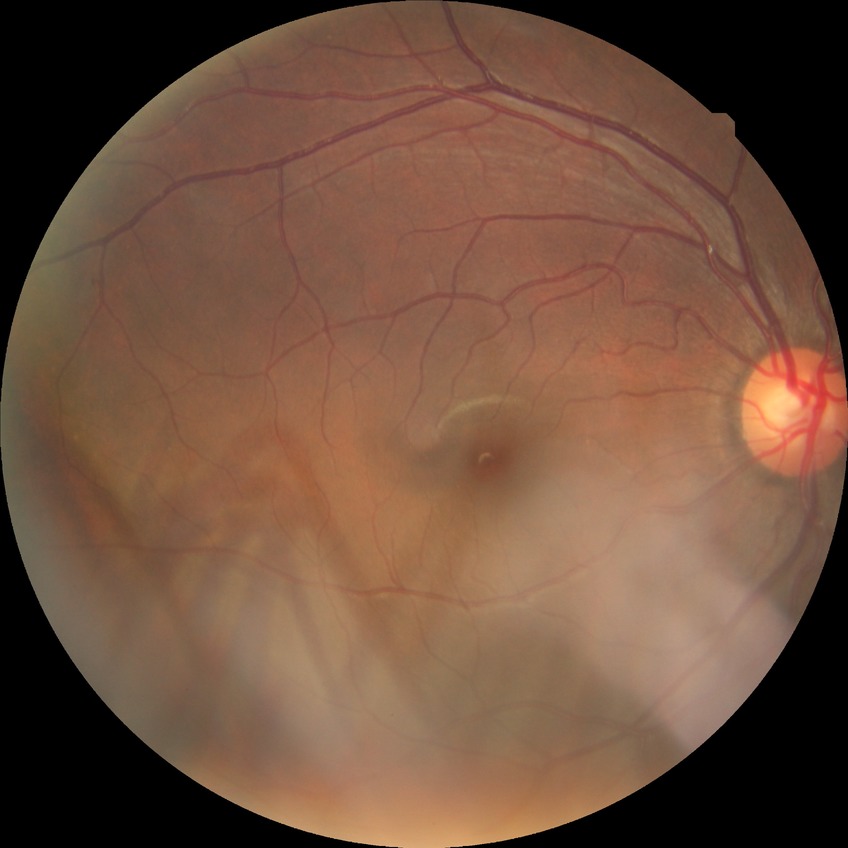 Assessment:
- diabetic retinopathy (DR): no diabetic retinopathy (NDR)